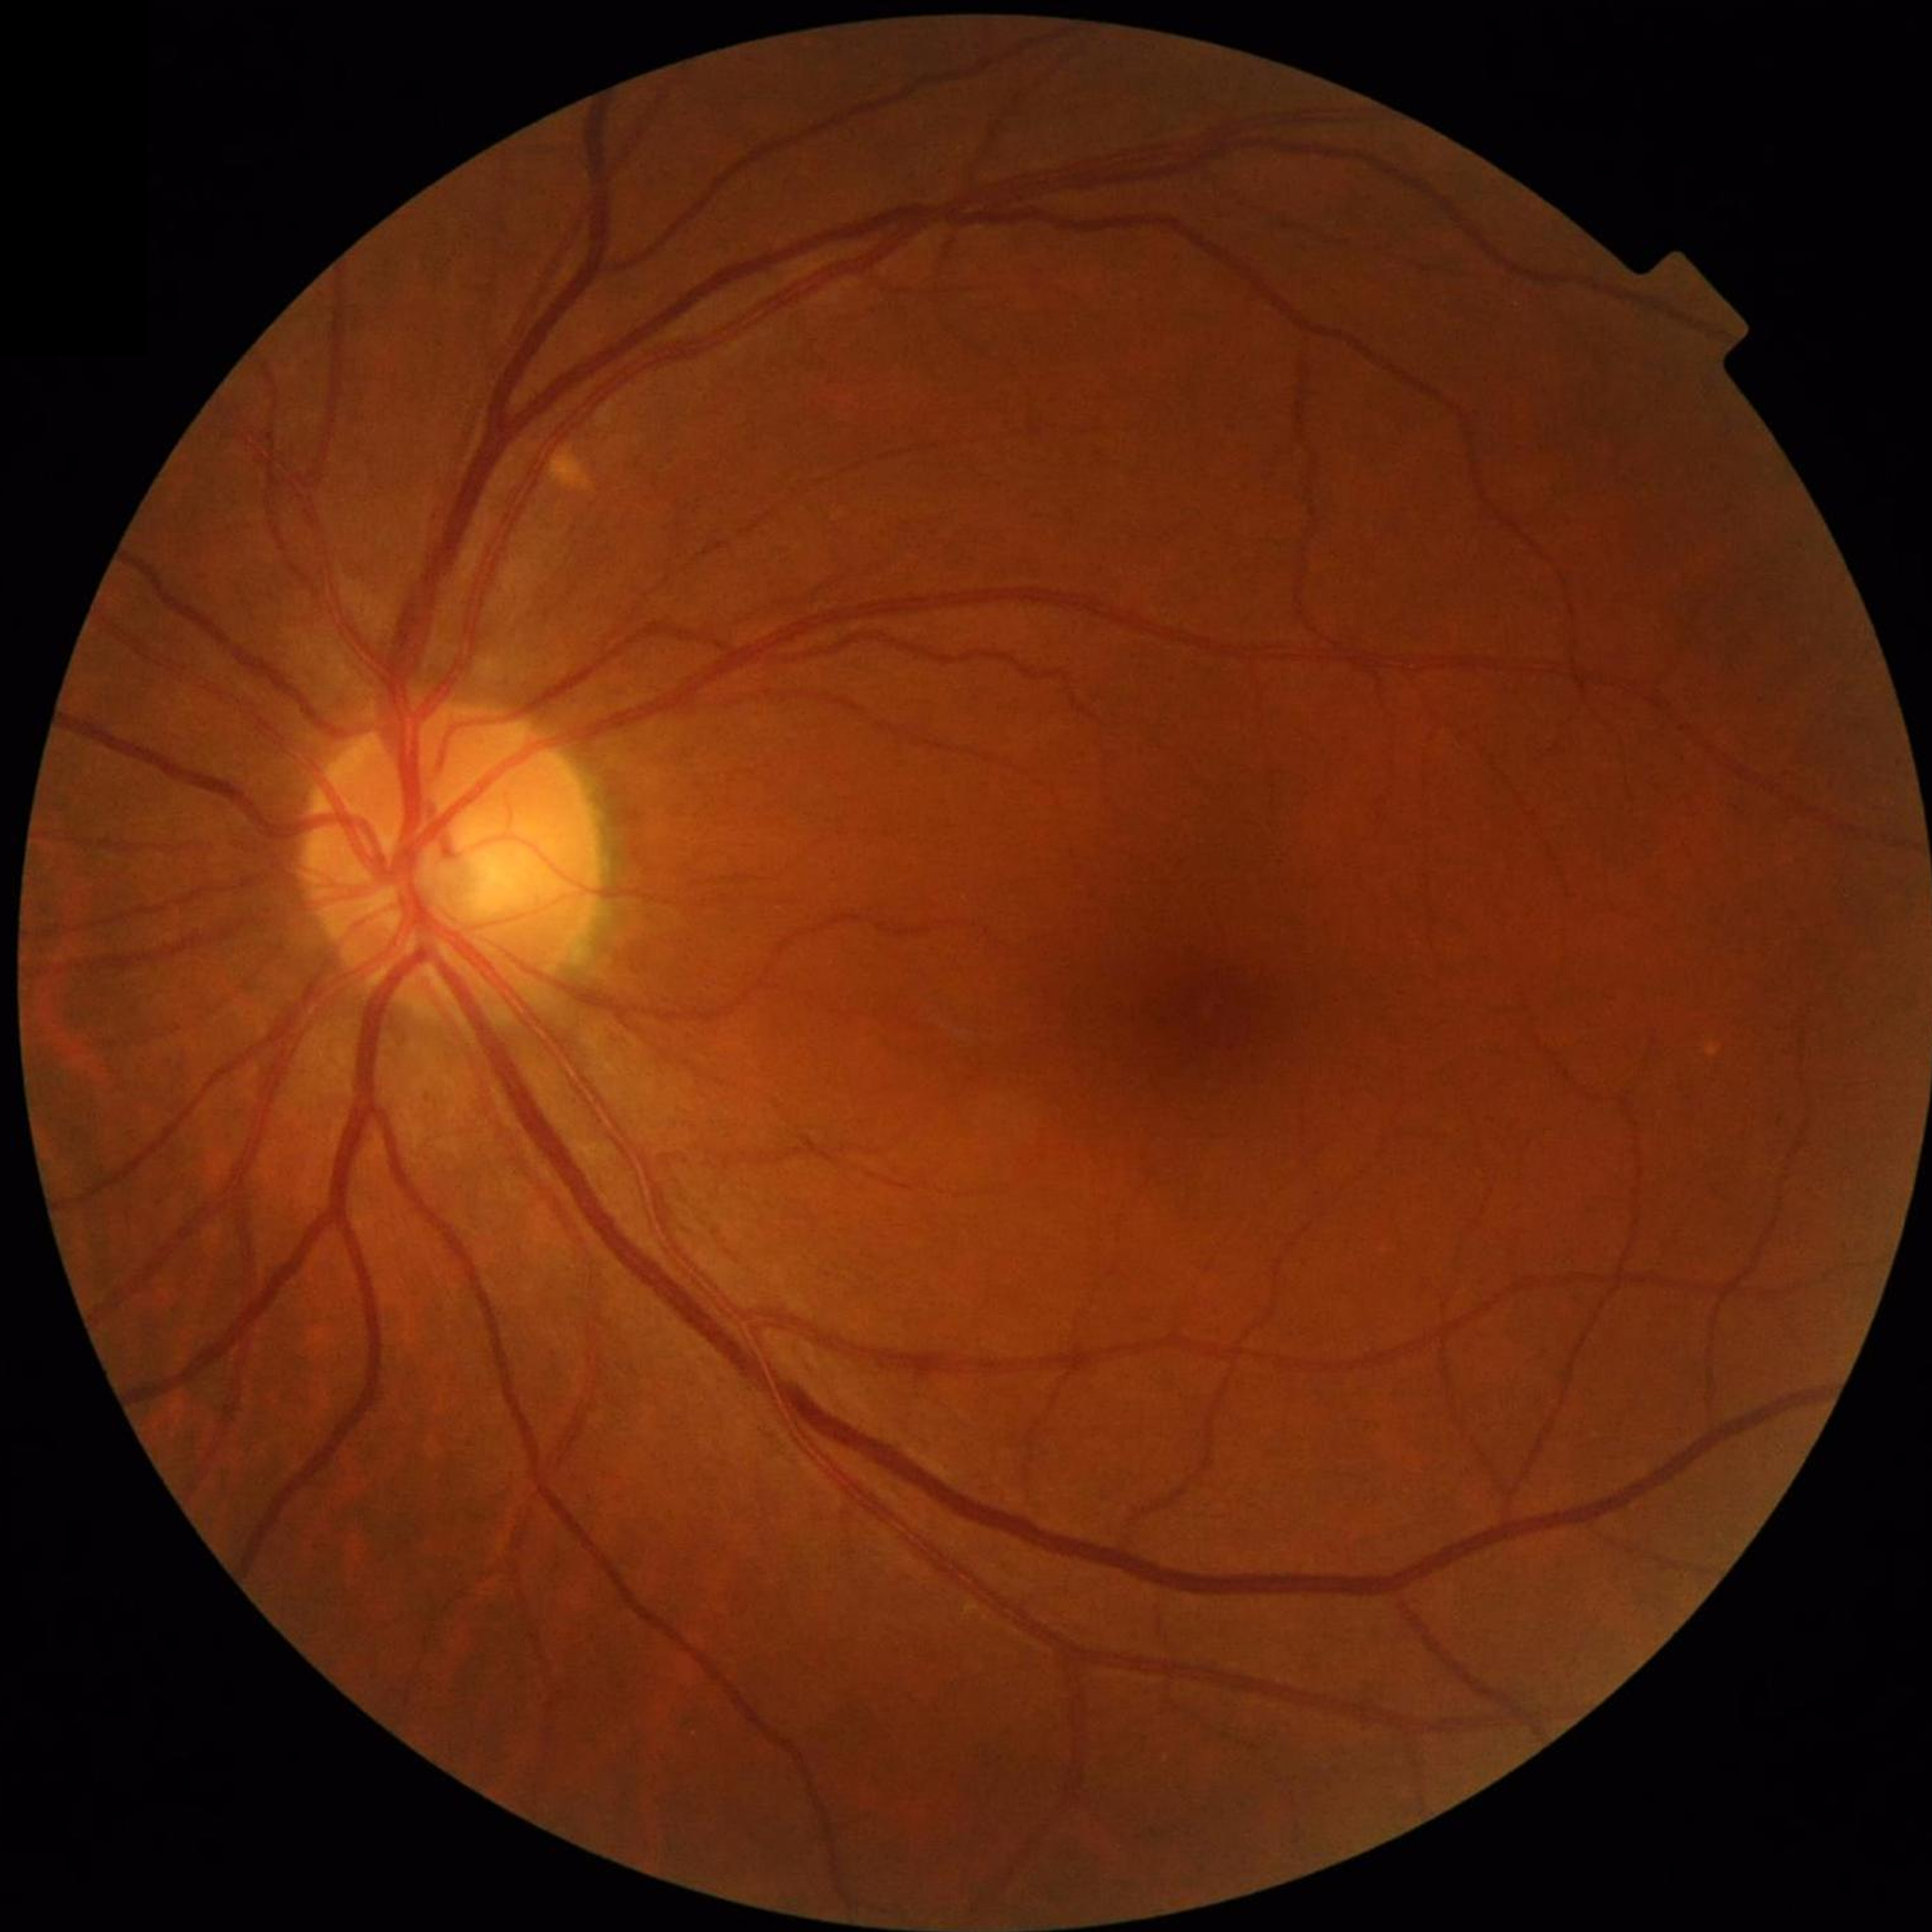 Clinical diagnosis: no AMD, DR, or glaucomatous findings.